848x848px. Acquired with a NIDEK AFC-230:
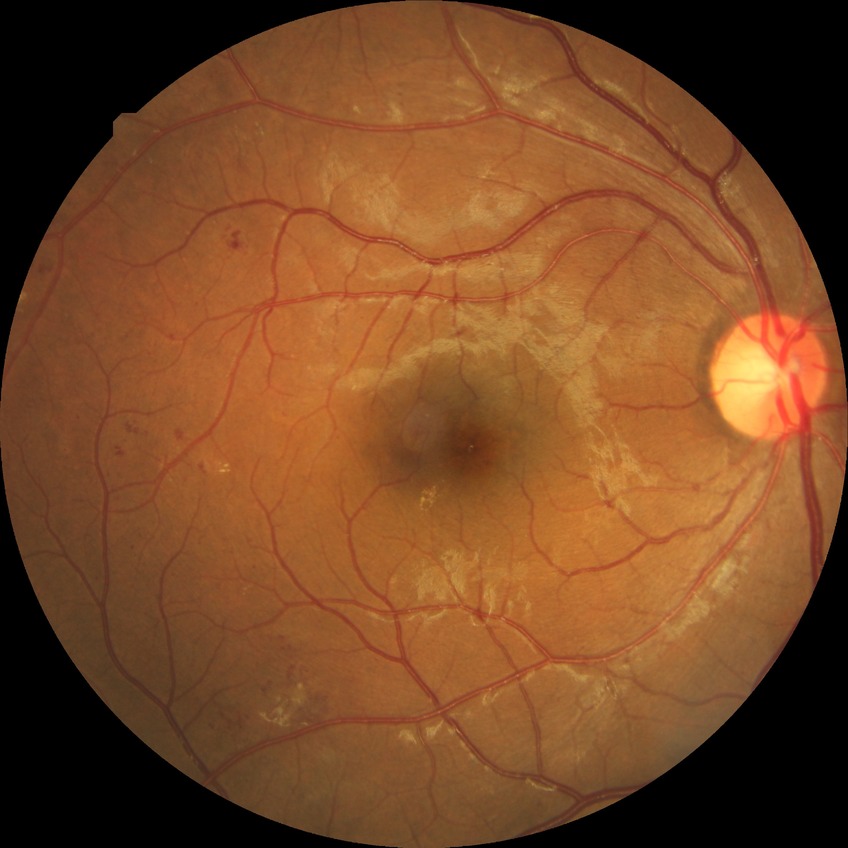 Retinopathy grade: simple diabetic retinopathy.